Color fundus image — 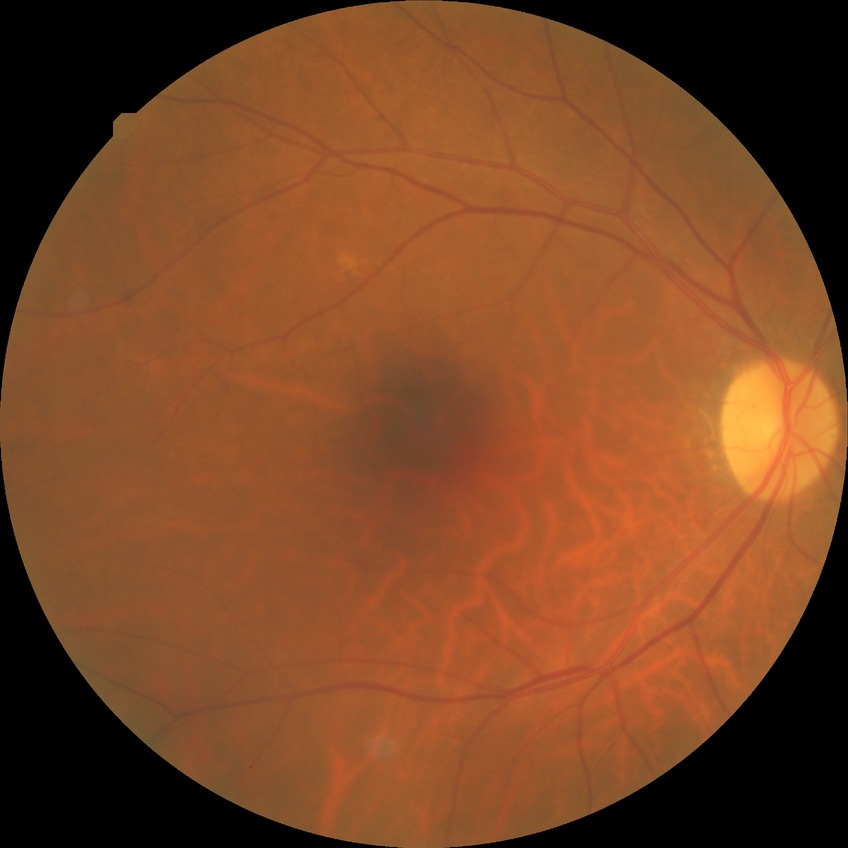
  davis_grade: no diabetic retinopathy (NDR)